No pharmacologic dilation.
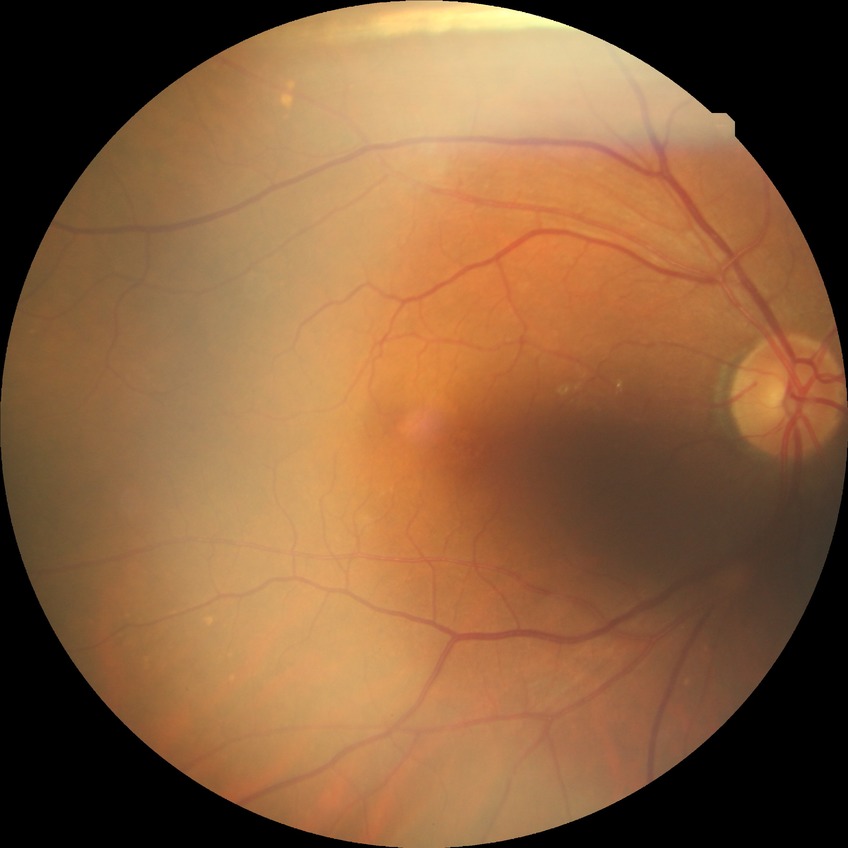
Davis grade is NDR.